1725 by 1721 pixels: 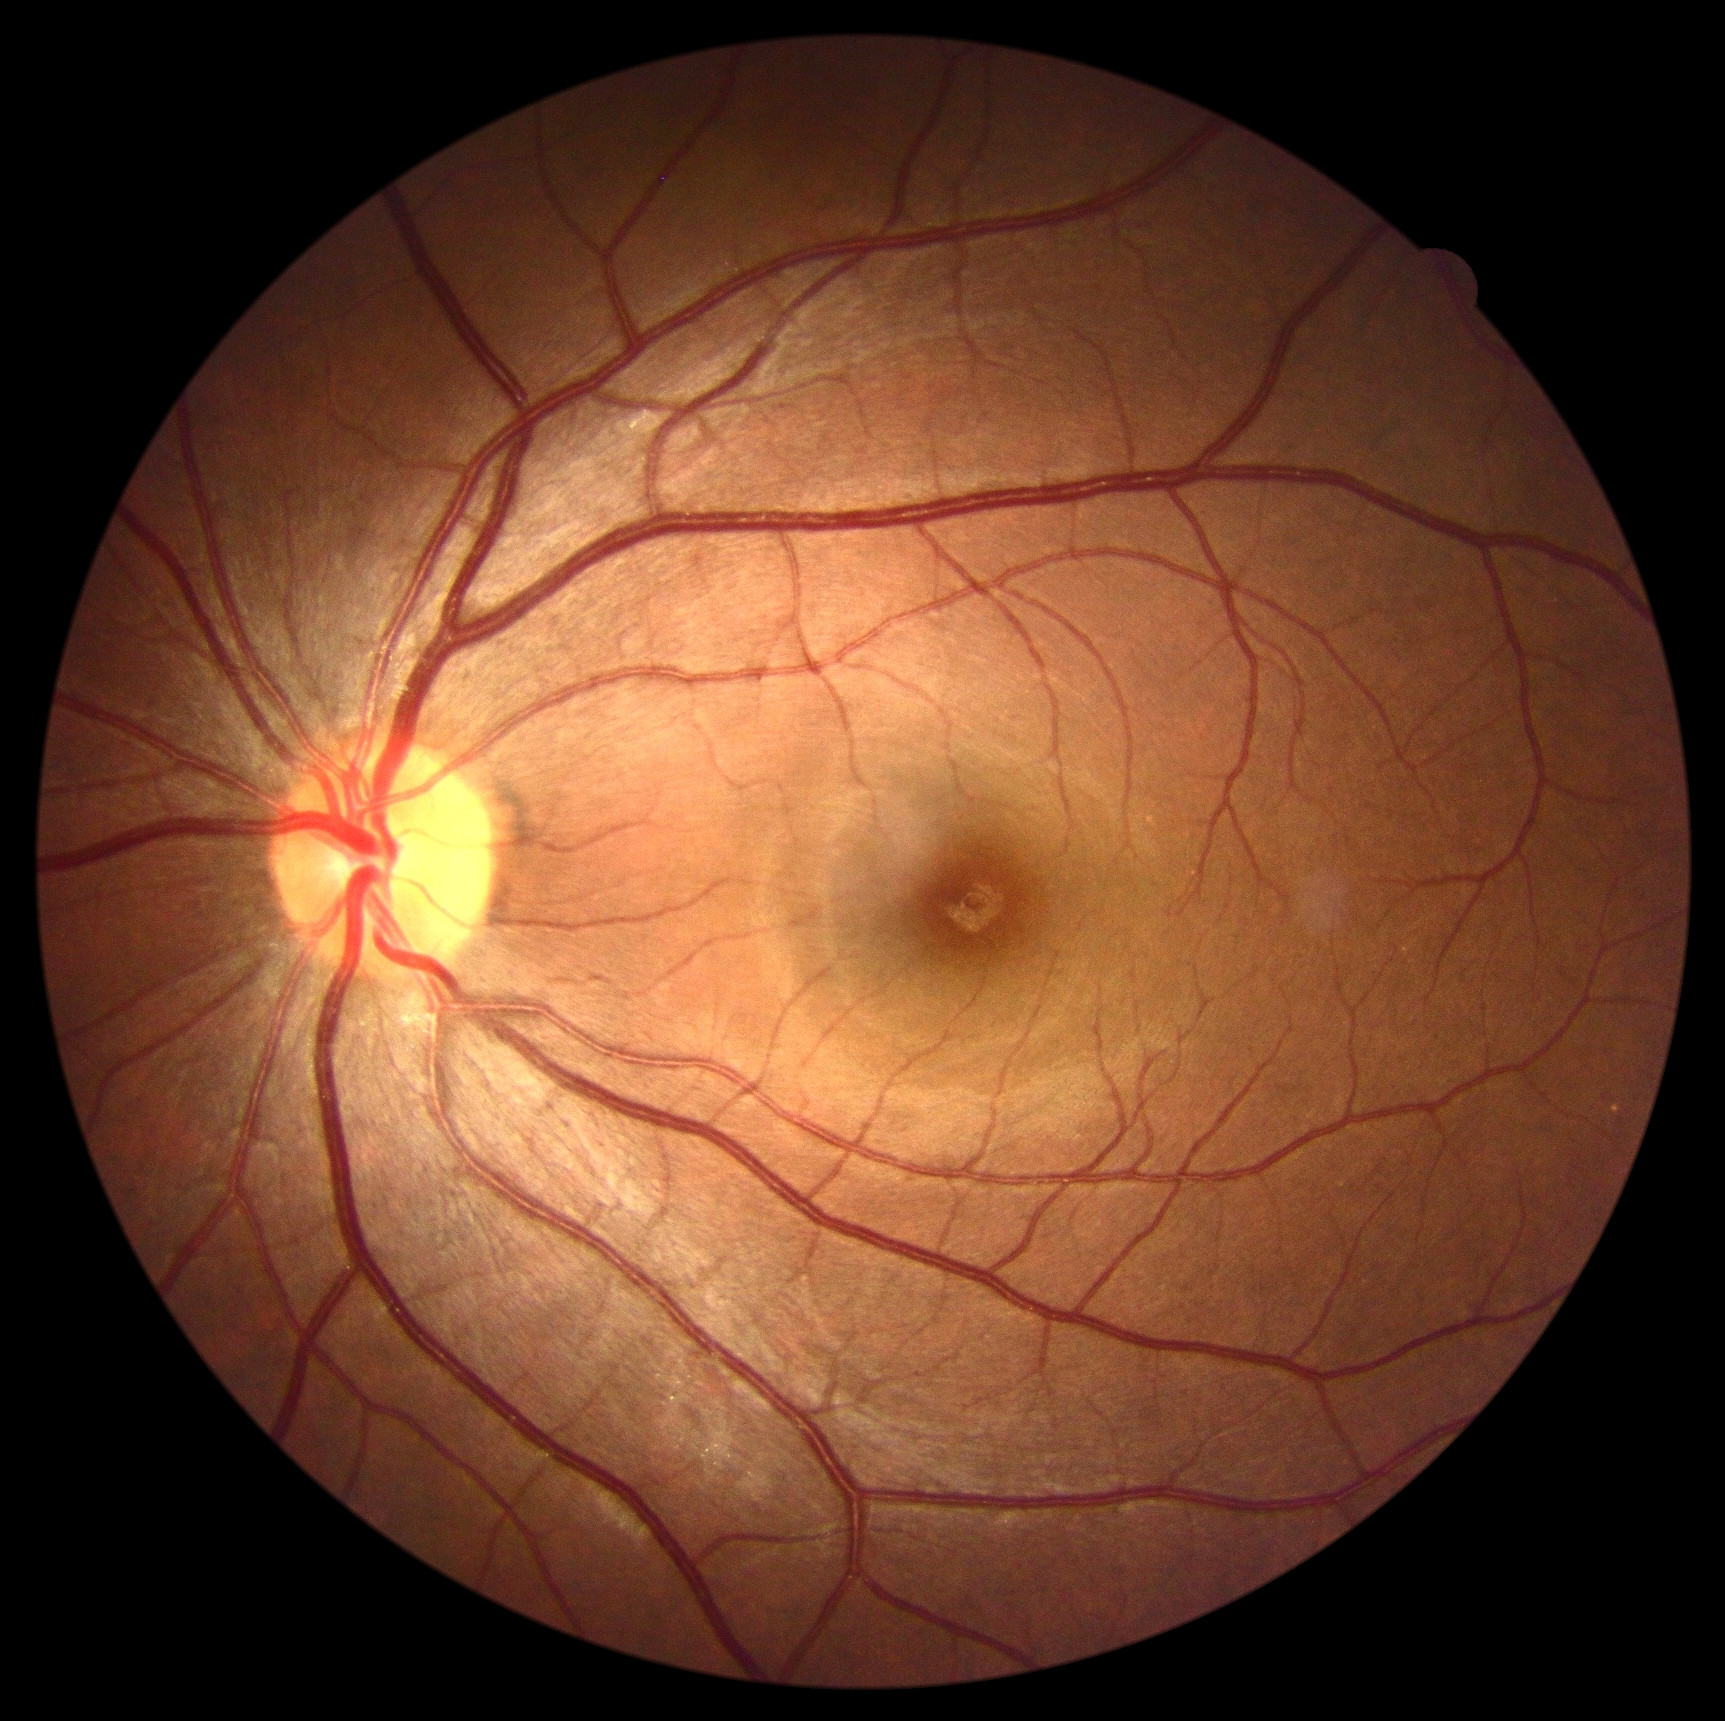
Findings:
• DR grade: no apparent diabetic retinopathy (0) — no visible signs of diabetic retinopathy
• DR impression: negative for DR